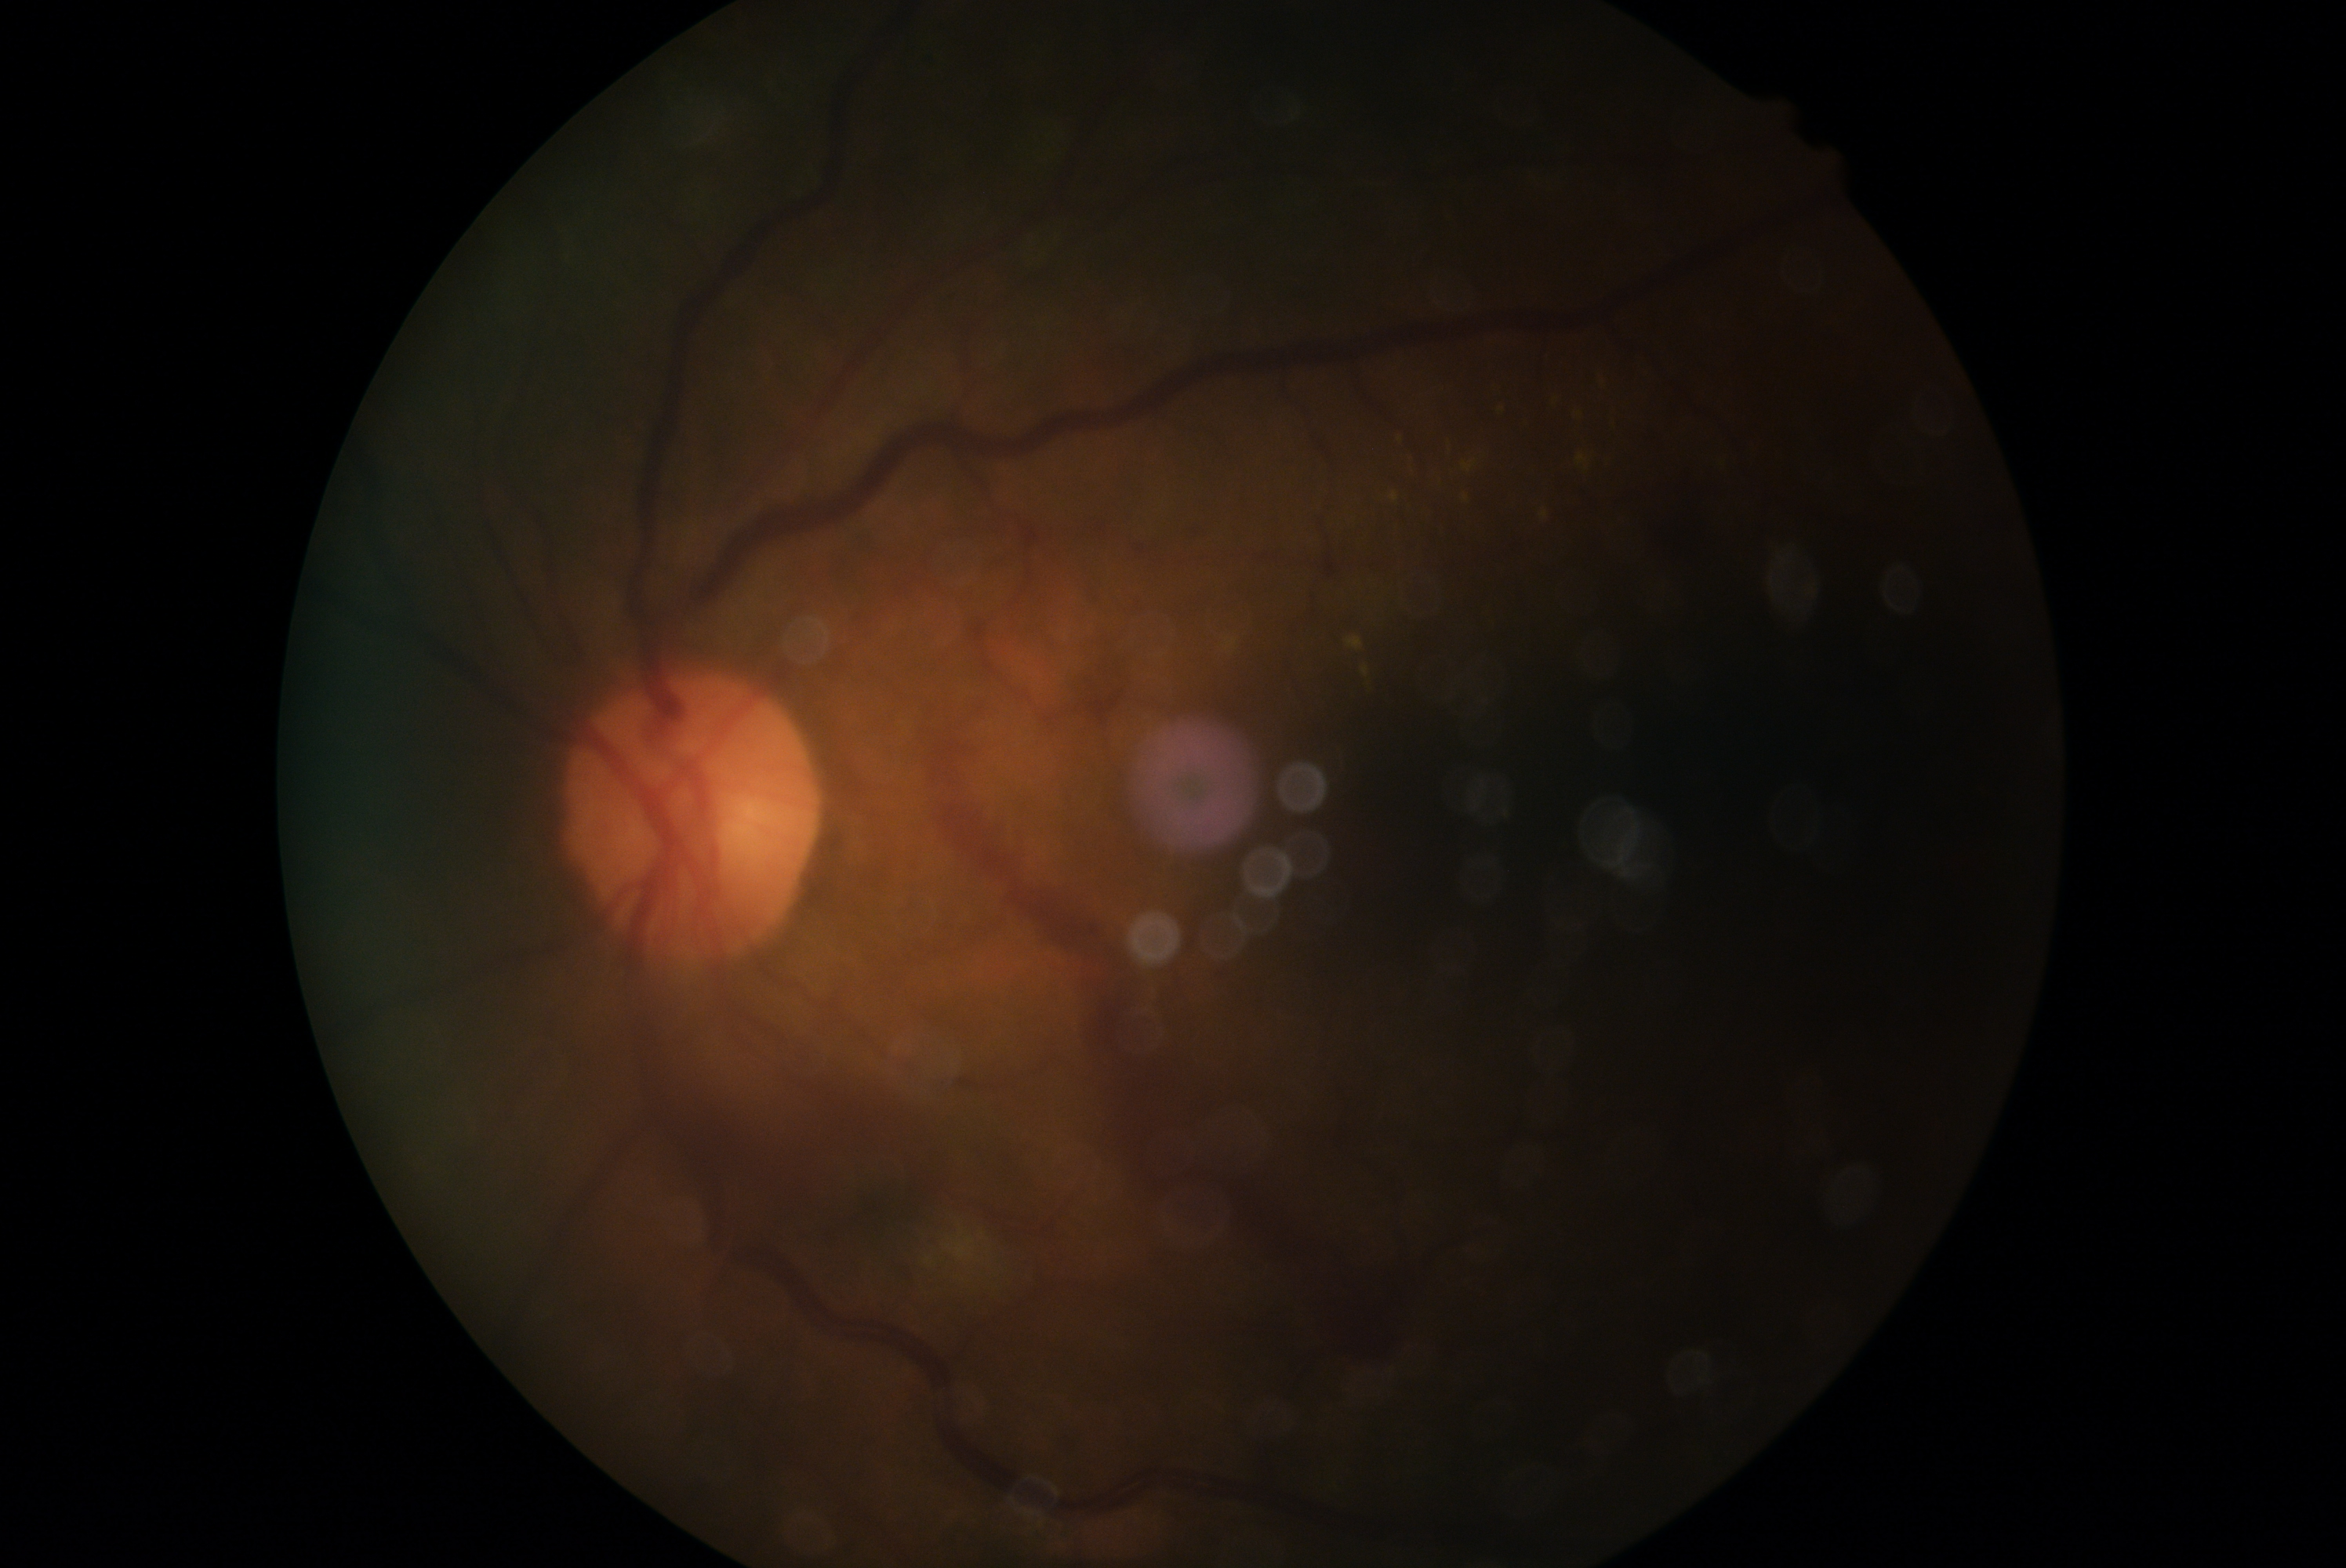
Diabetic retinopathy is grade 4.